CFP.
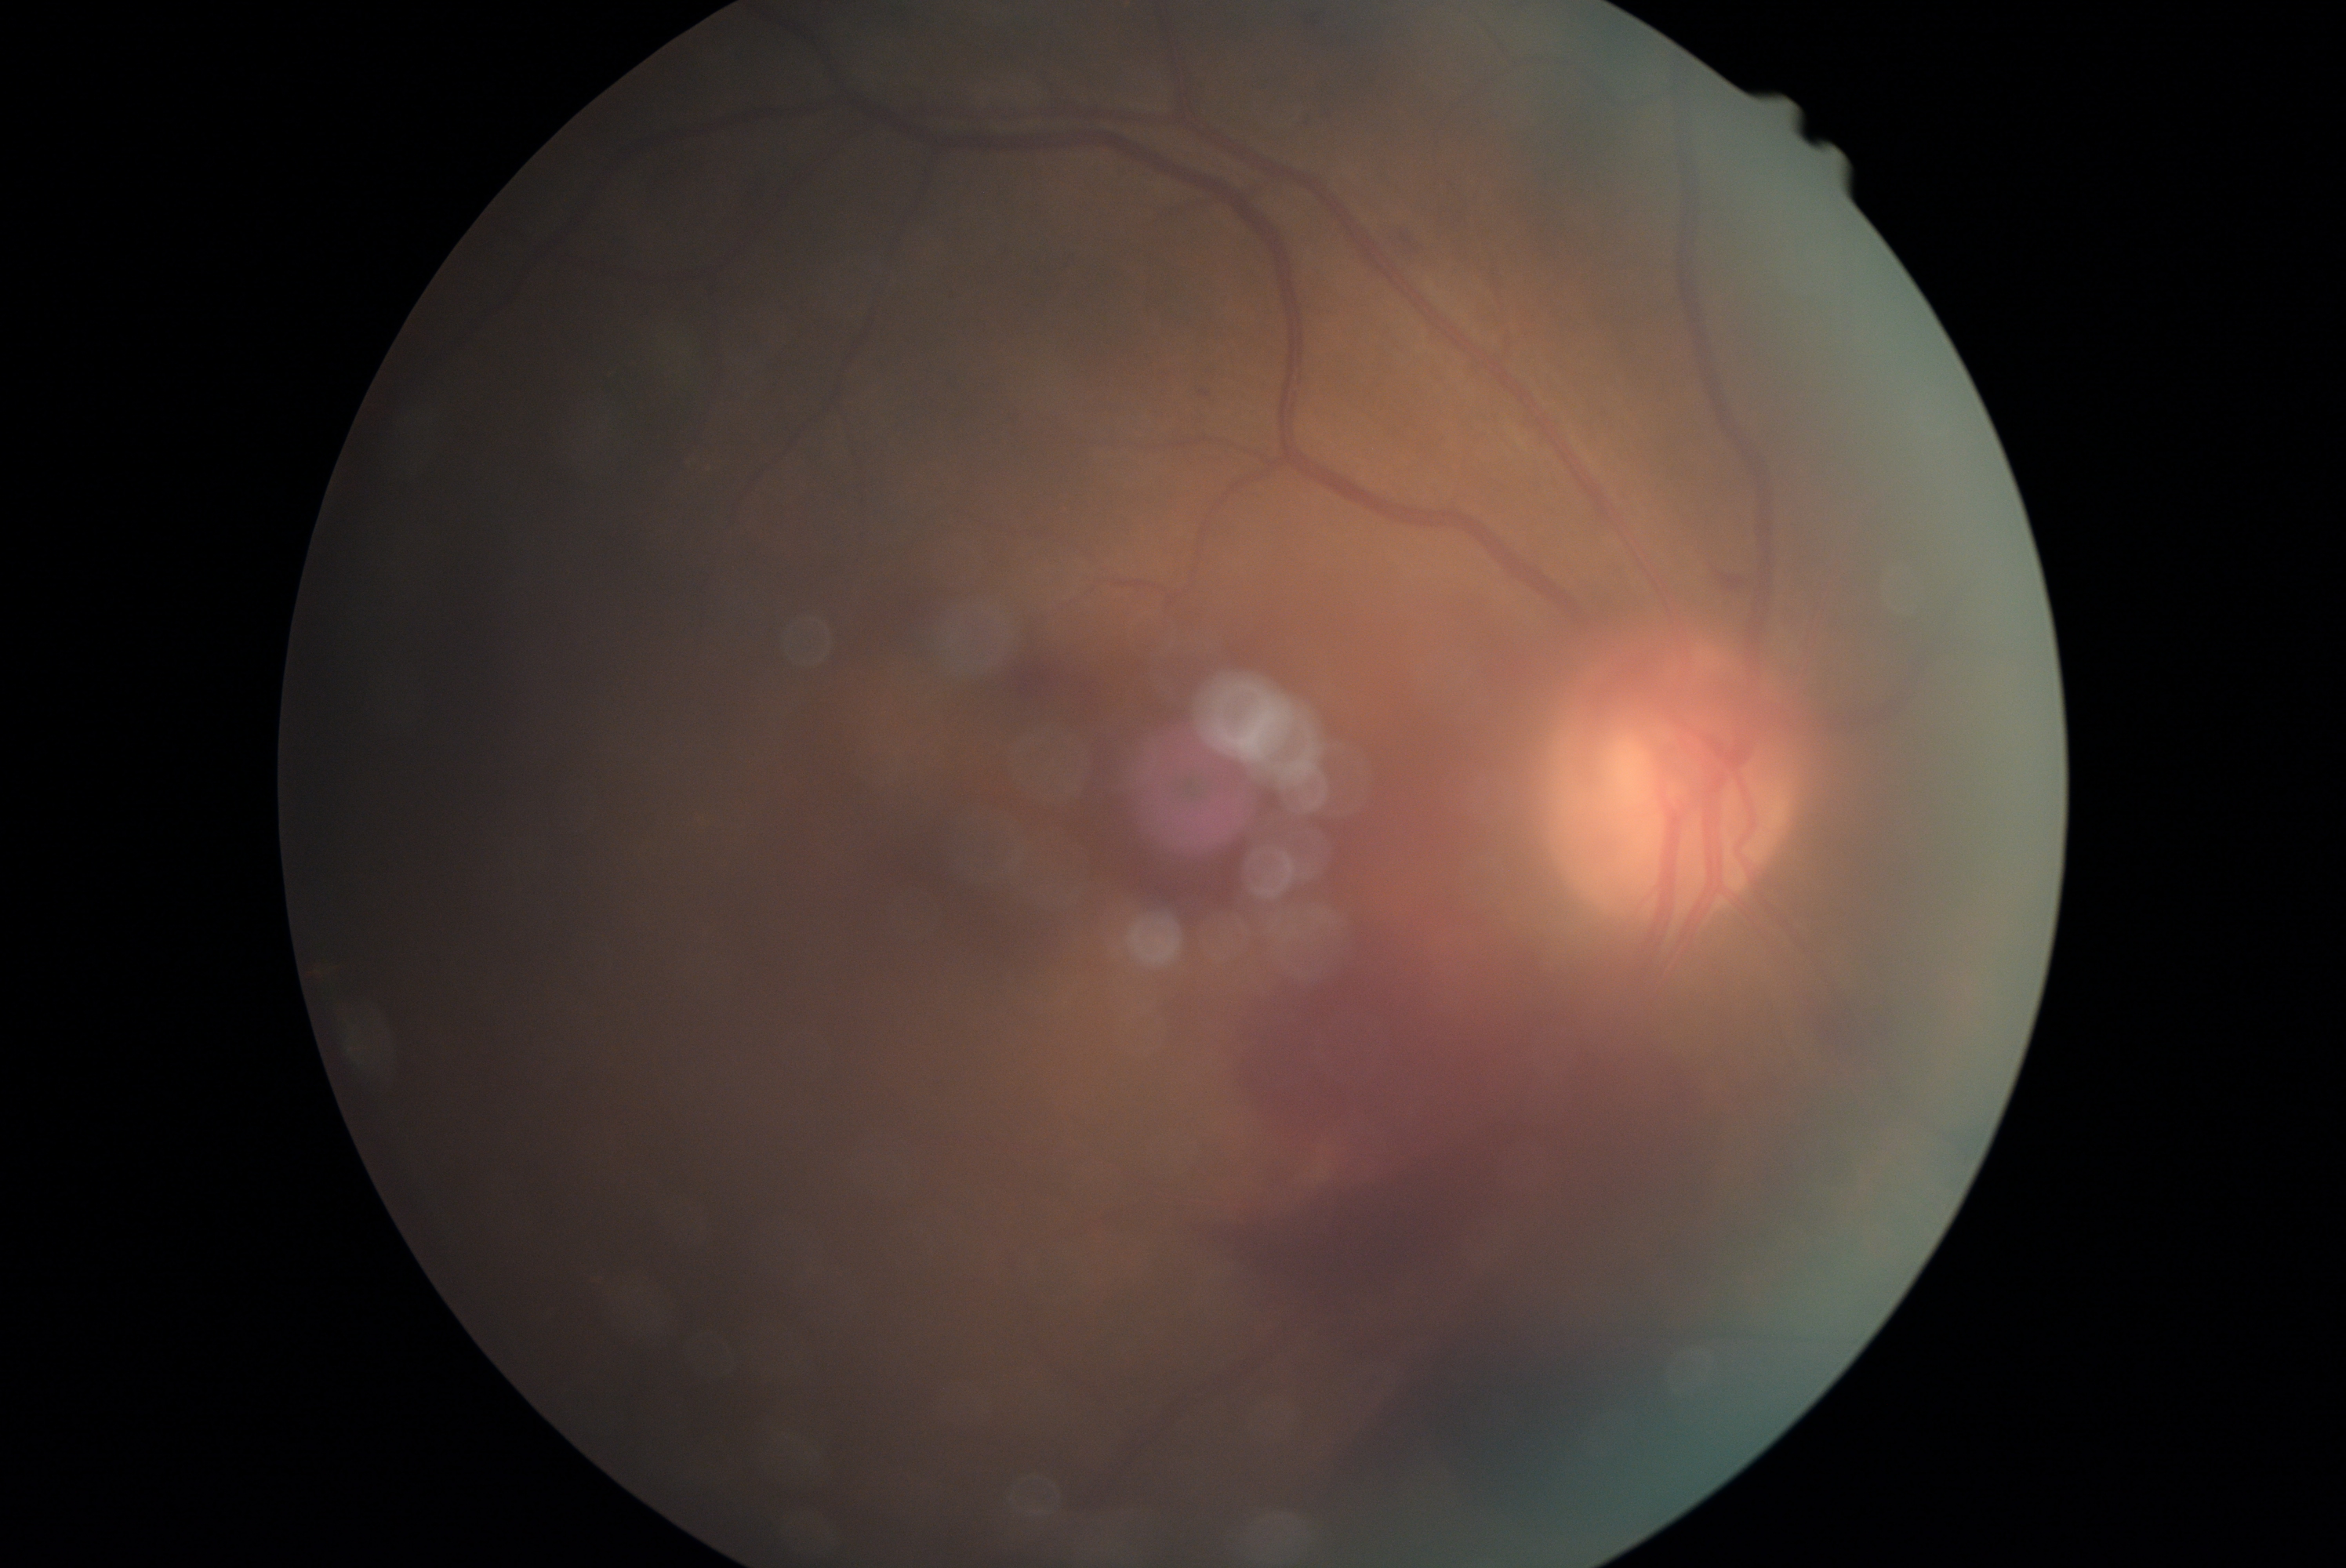 Diabetic retinopathy grade is PDR (4).